DR severity per modified Davis staging.
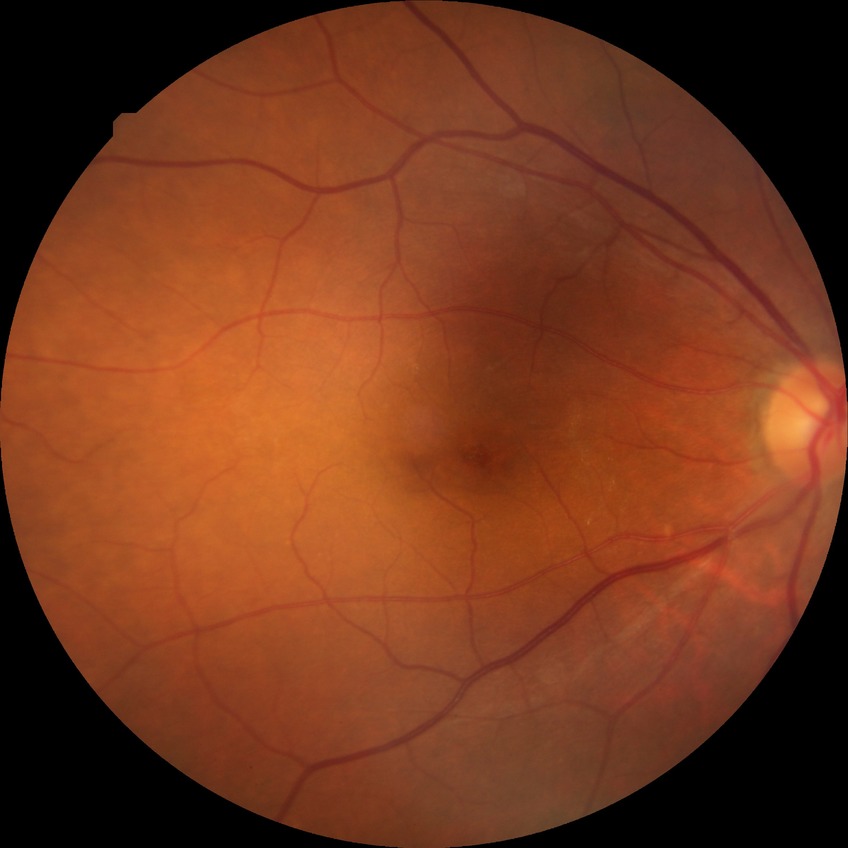

Modified Davis classification is no diabetic retinopathy.